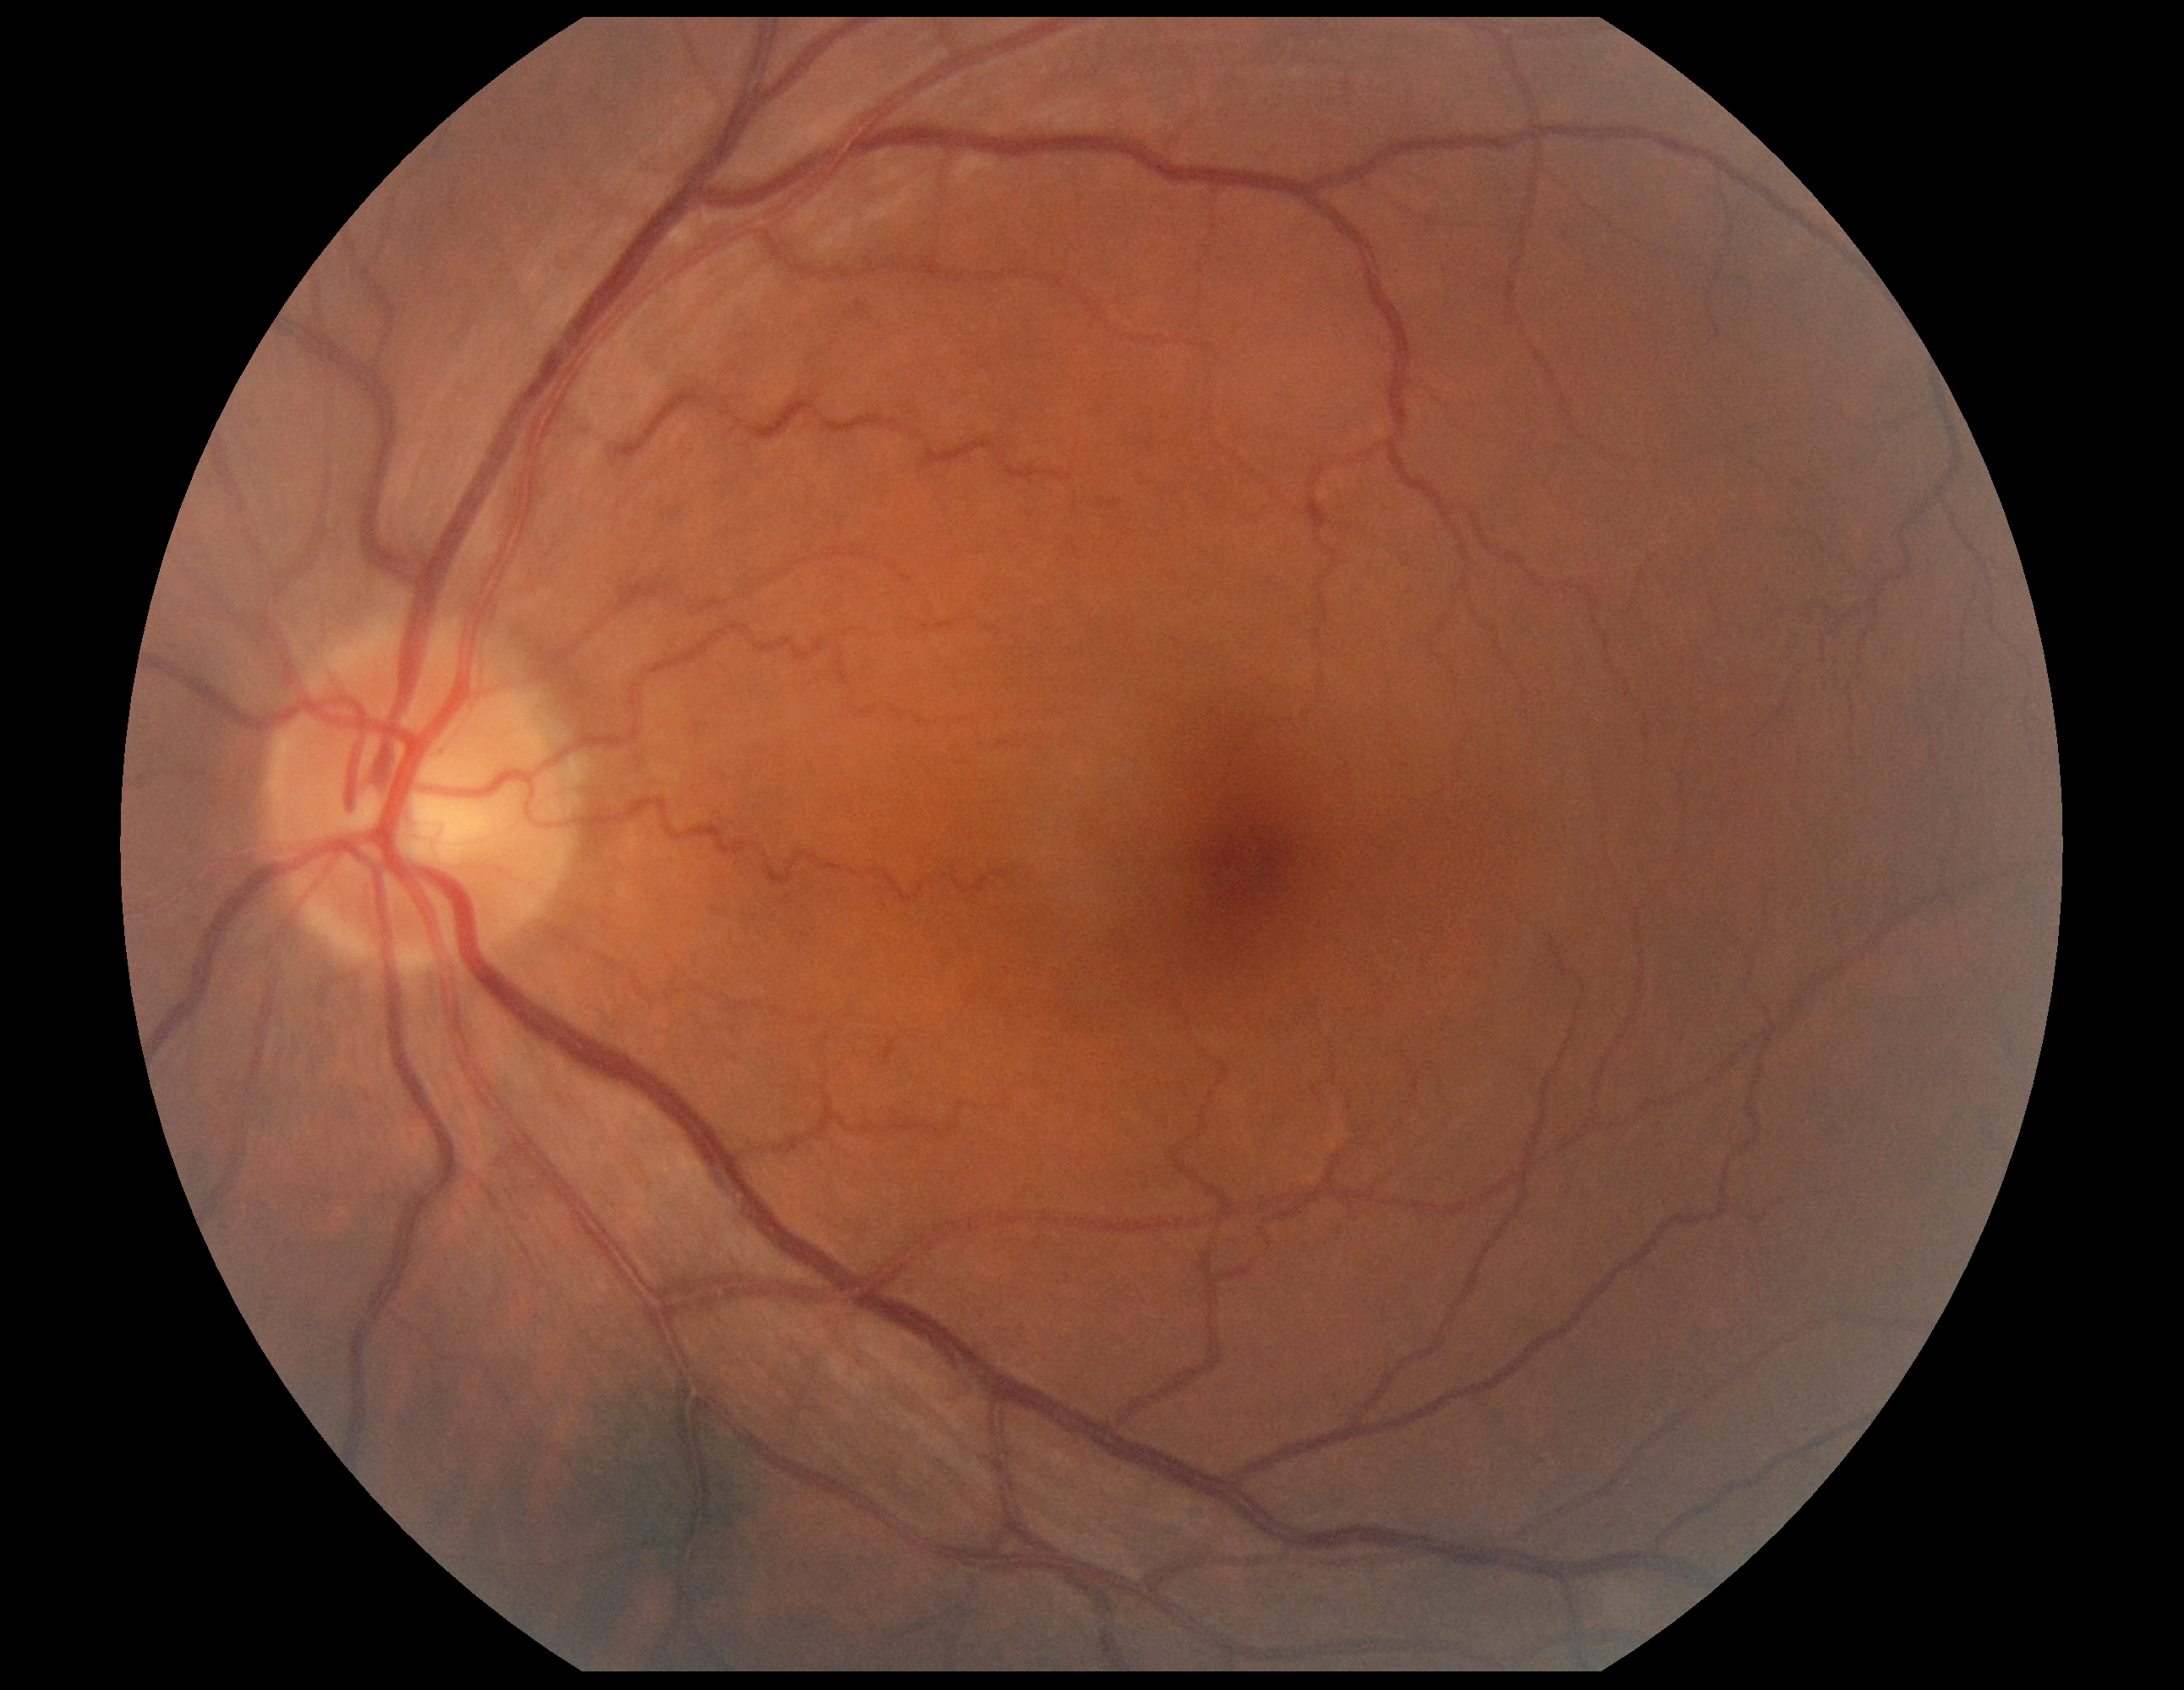
No DR findings. DR stage is 0/4 — no visible signs of diabetic retinopathy.